No pharmacologic dilation. 45° field of view. Retinal fundus photograph. Camera: NIDEK AFC-230: 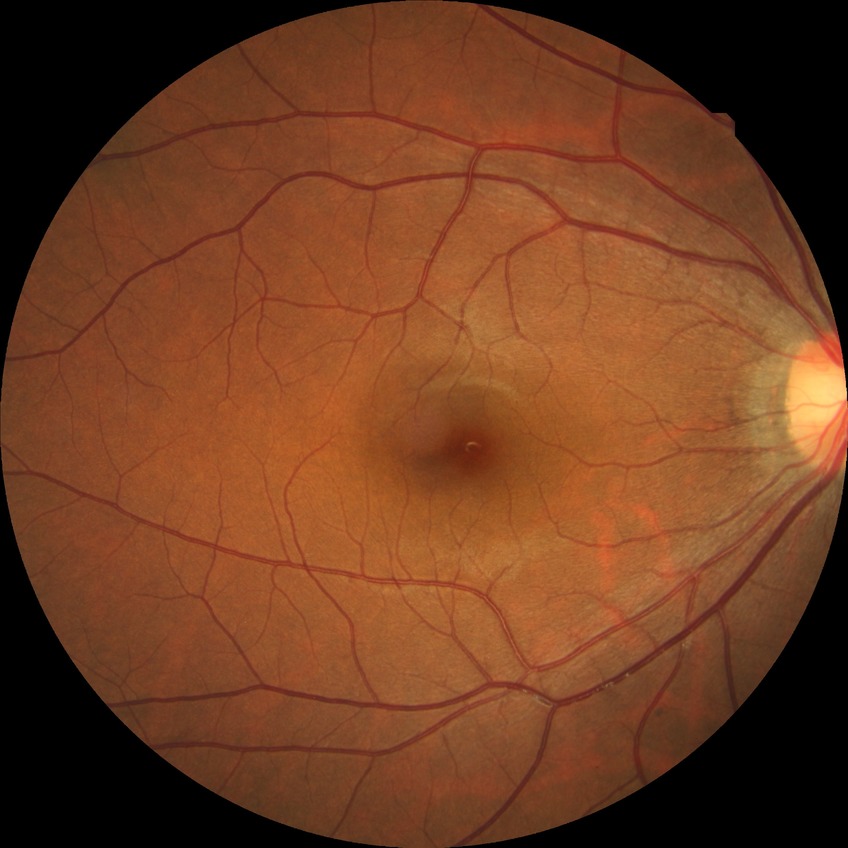

Diabetic retinopathy grade is no diabetic retinopathy.